45° field of view; DR severity per modified Davis staging; NIDEK AFC-230
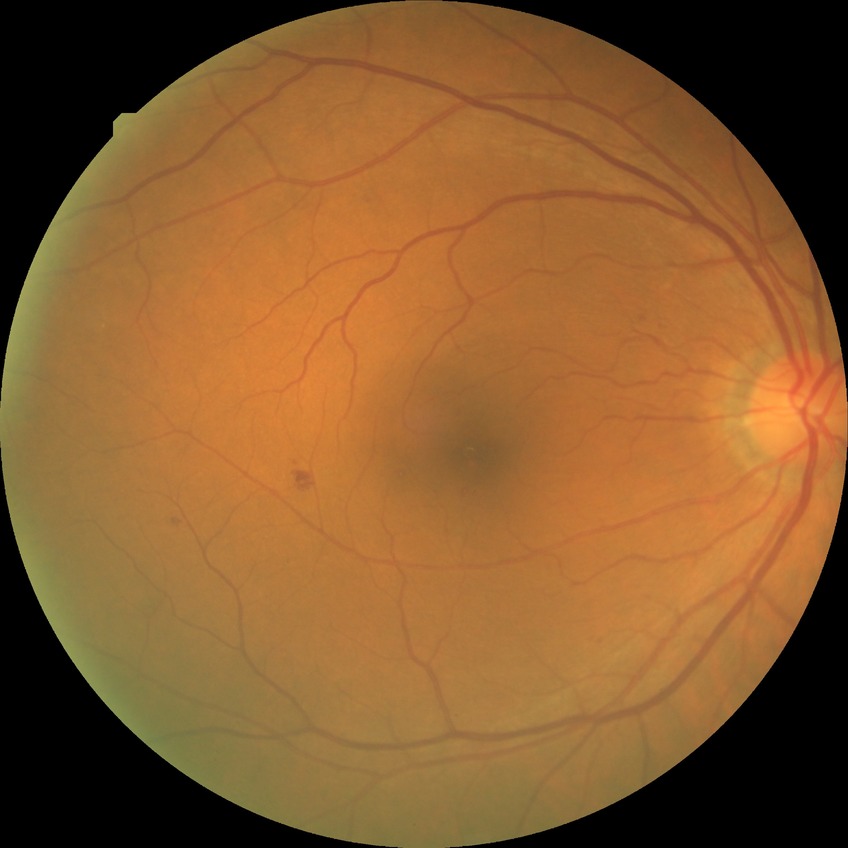

Diabetic retinopathy (DR) is SDR (simple diabetic retinopathy).